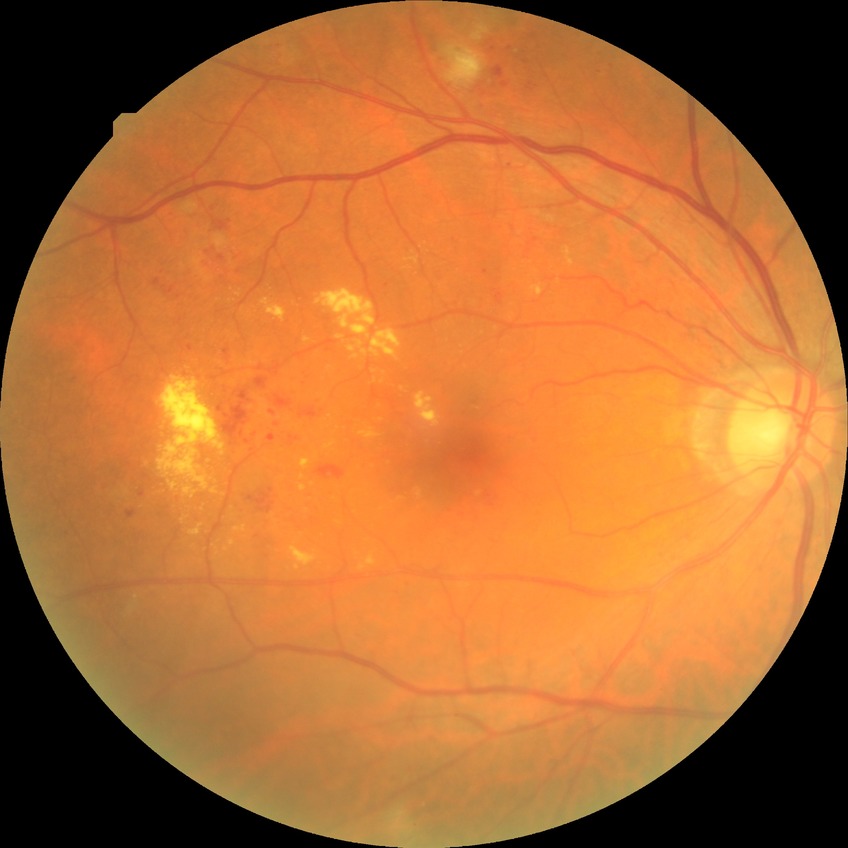

Diabetic retinopathy (DR) is pre-proliferative diabetic retinopathy (PPDR).